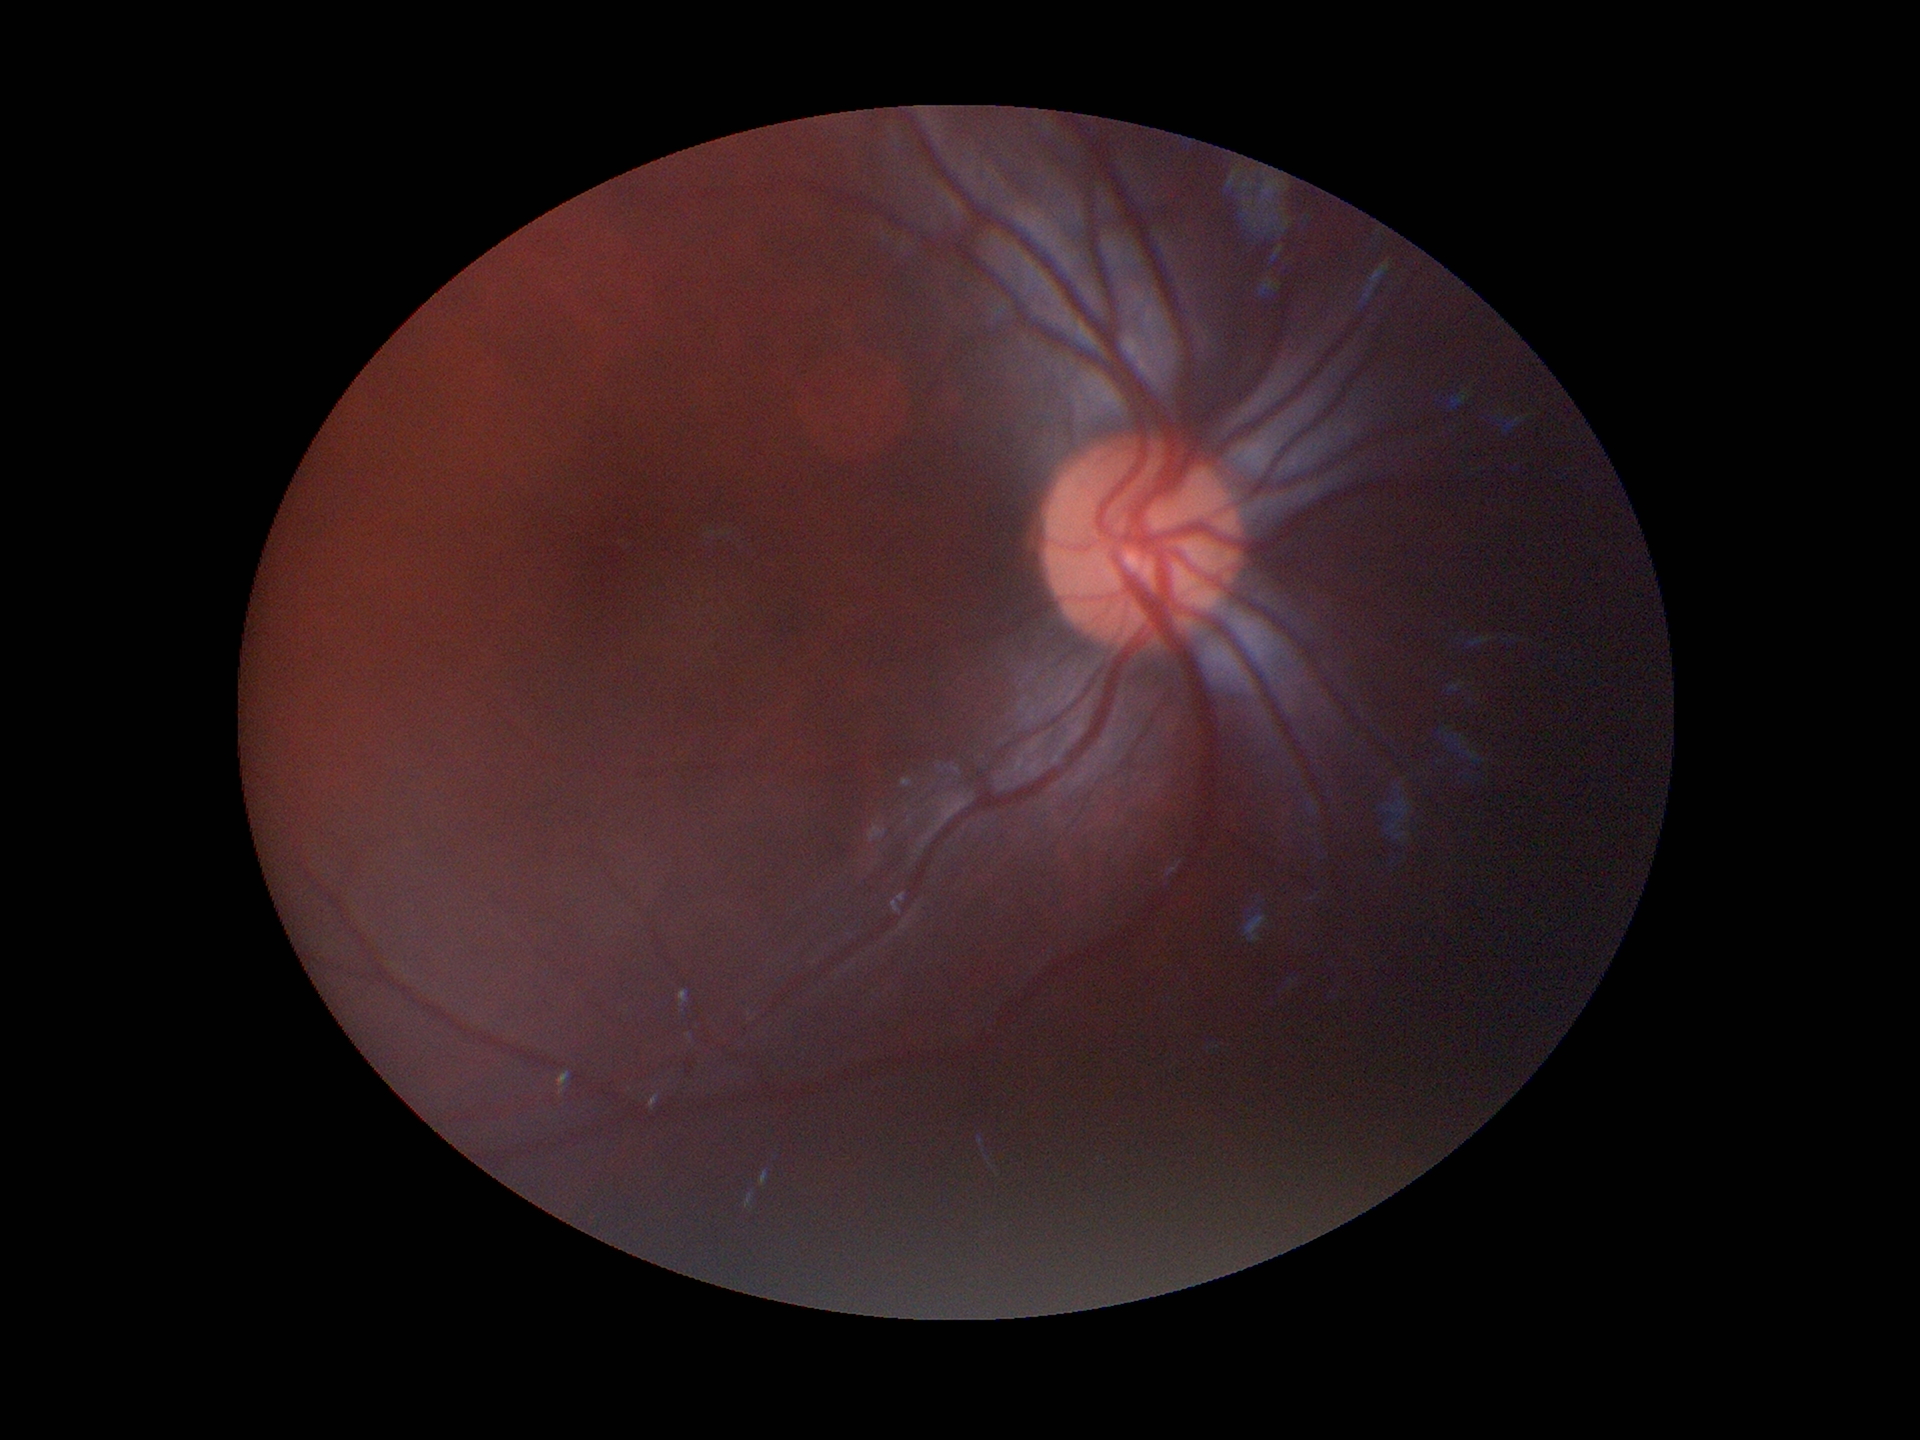
VCDR: 0.48
Glaucoma assessment: negative